Intraocular pressure: 15 mmHg · woman · 66 years old · non-mydriatic acquisition:
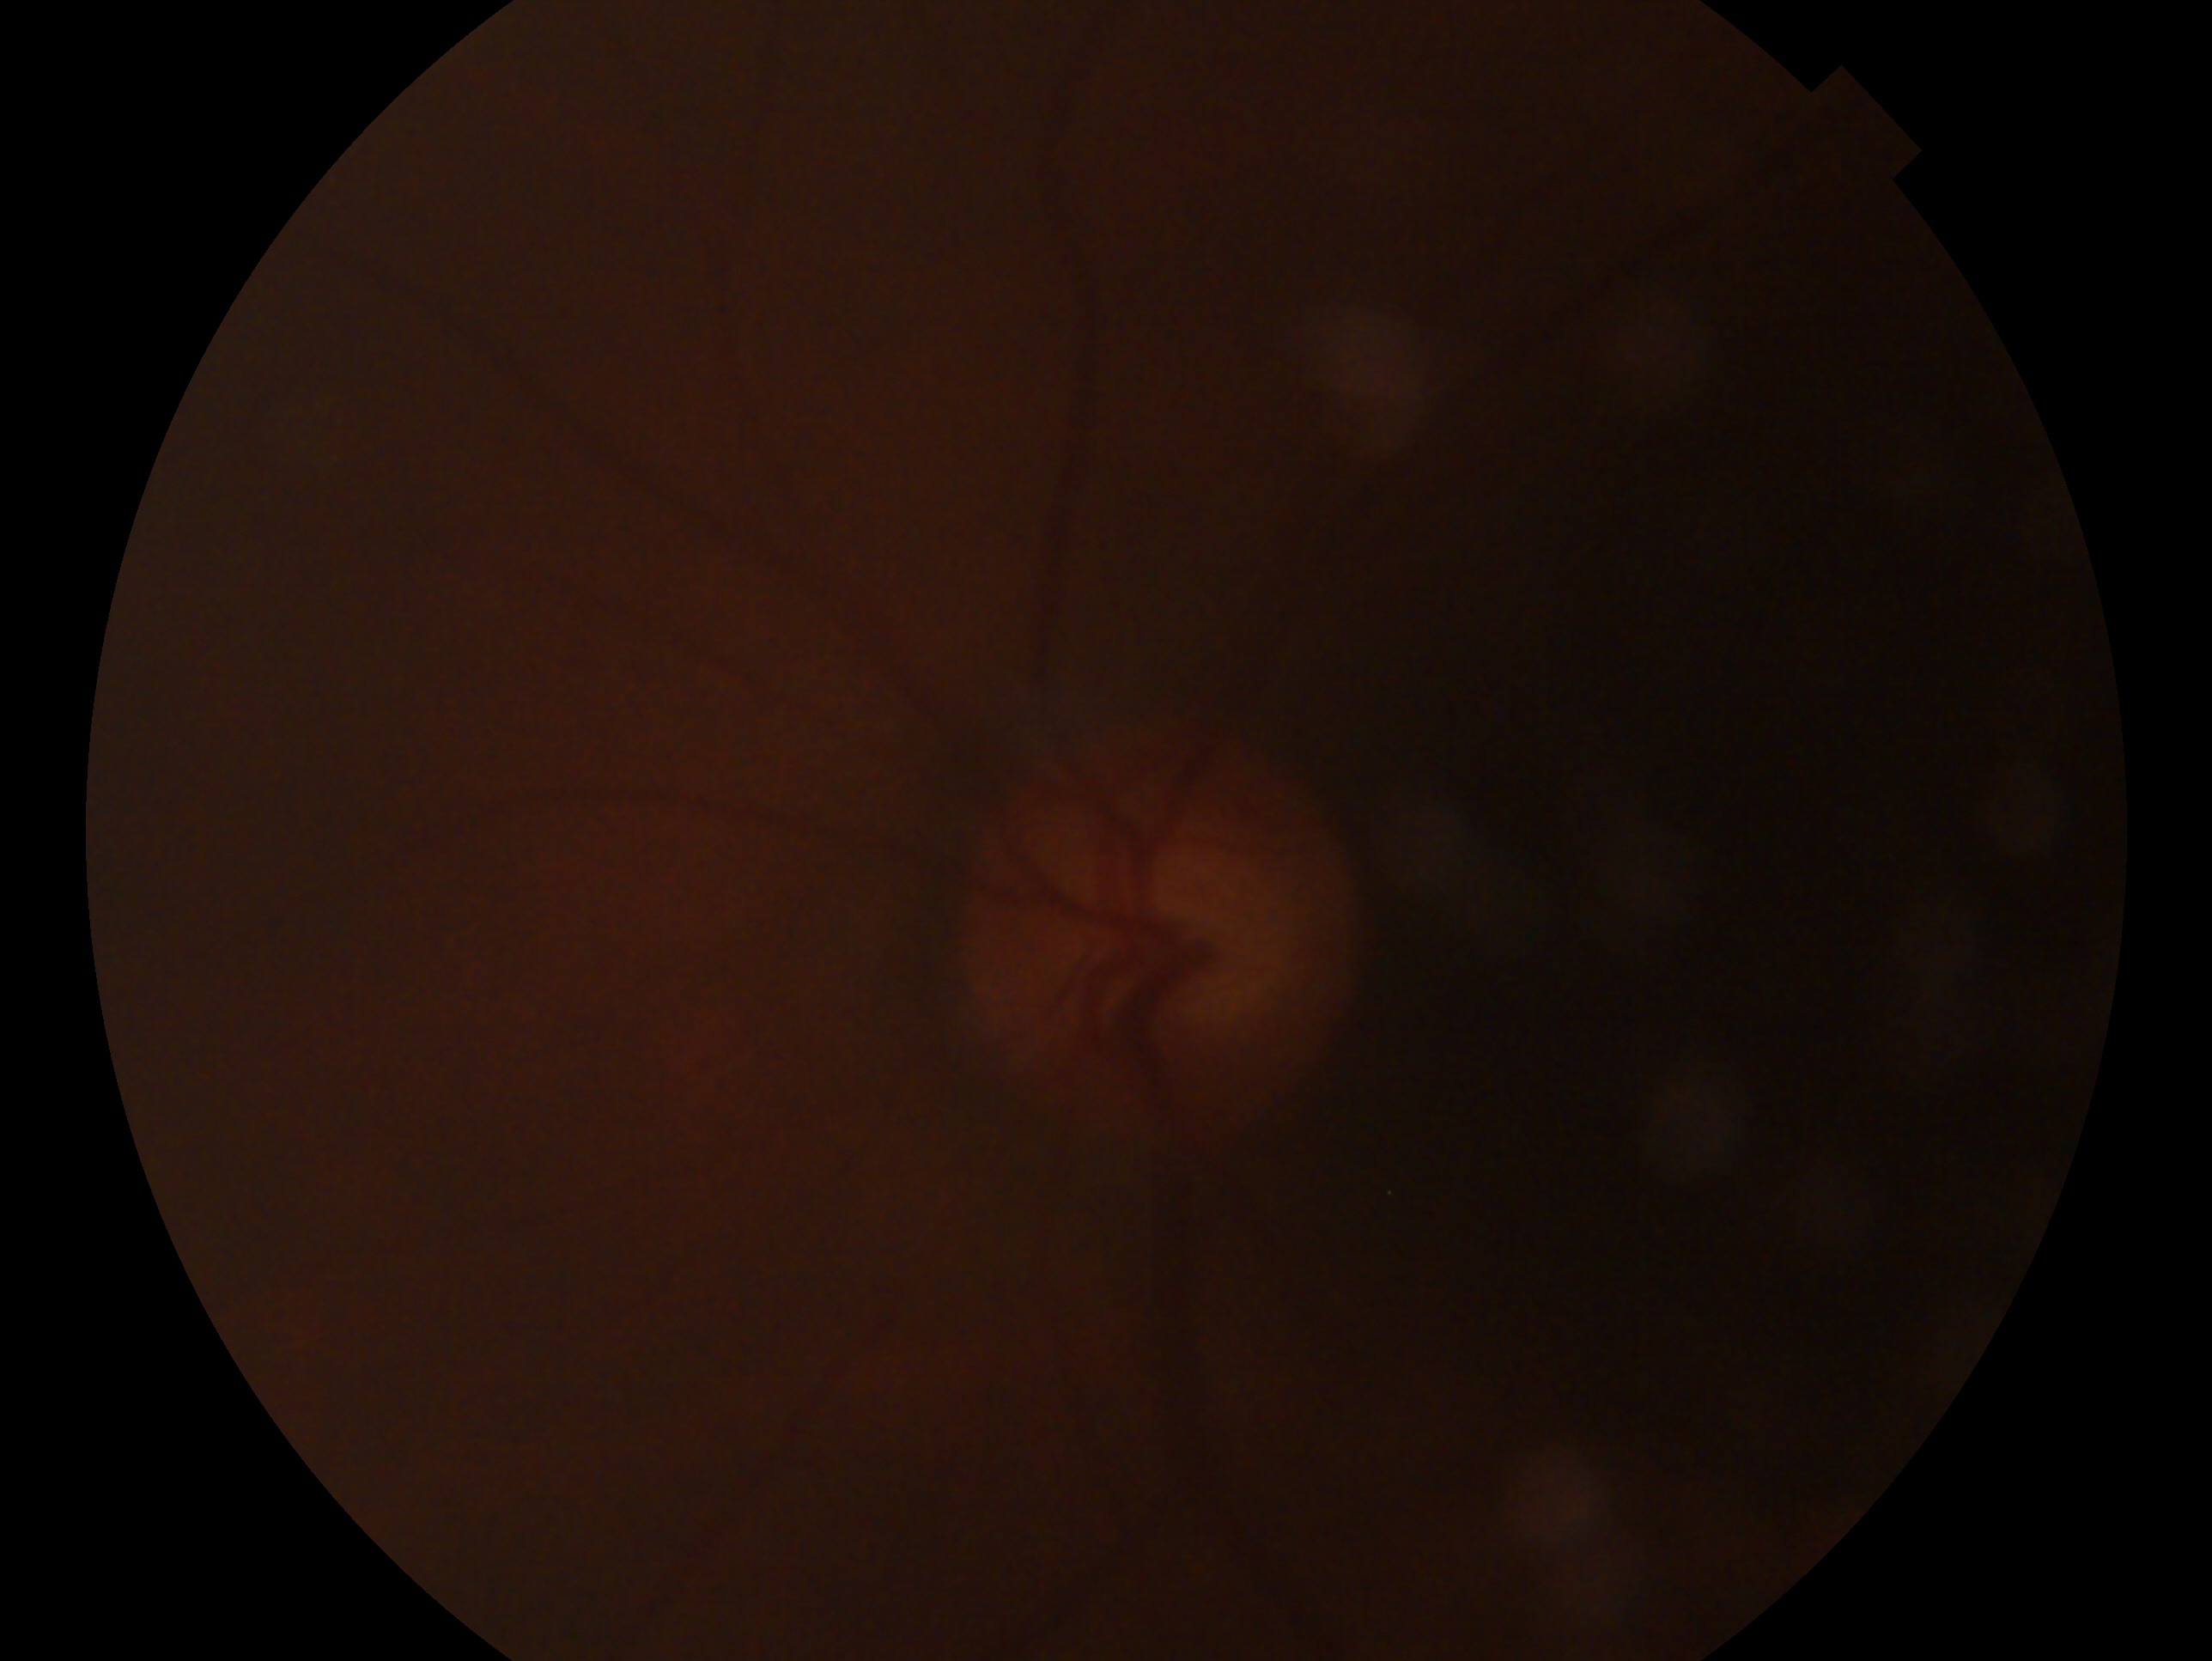 Imaged eye: oculus sinister. Clinical classification: no glaucomatous findings — no clinical evidence of glaucoma in this eye.